Pachymetry: 479 µm. Gender: M.
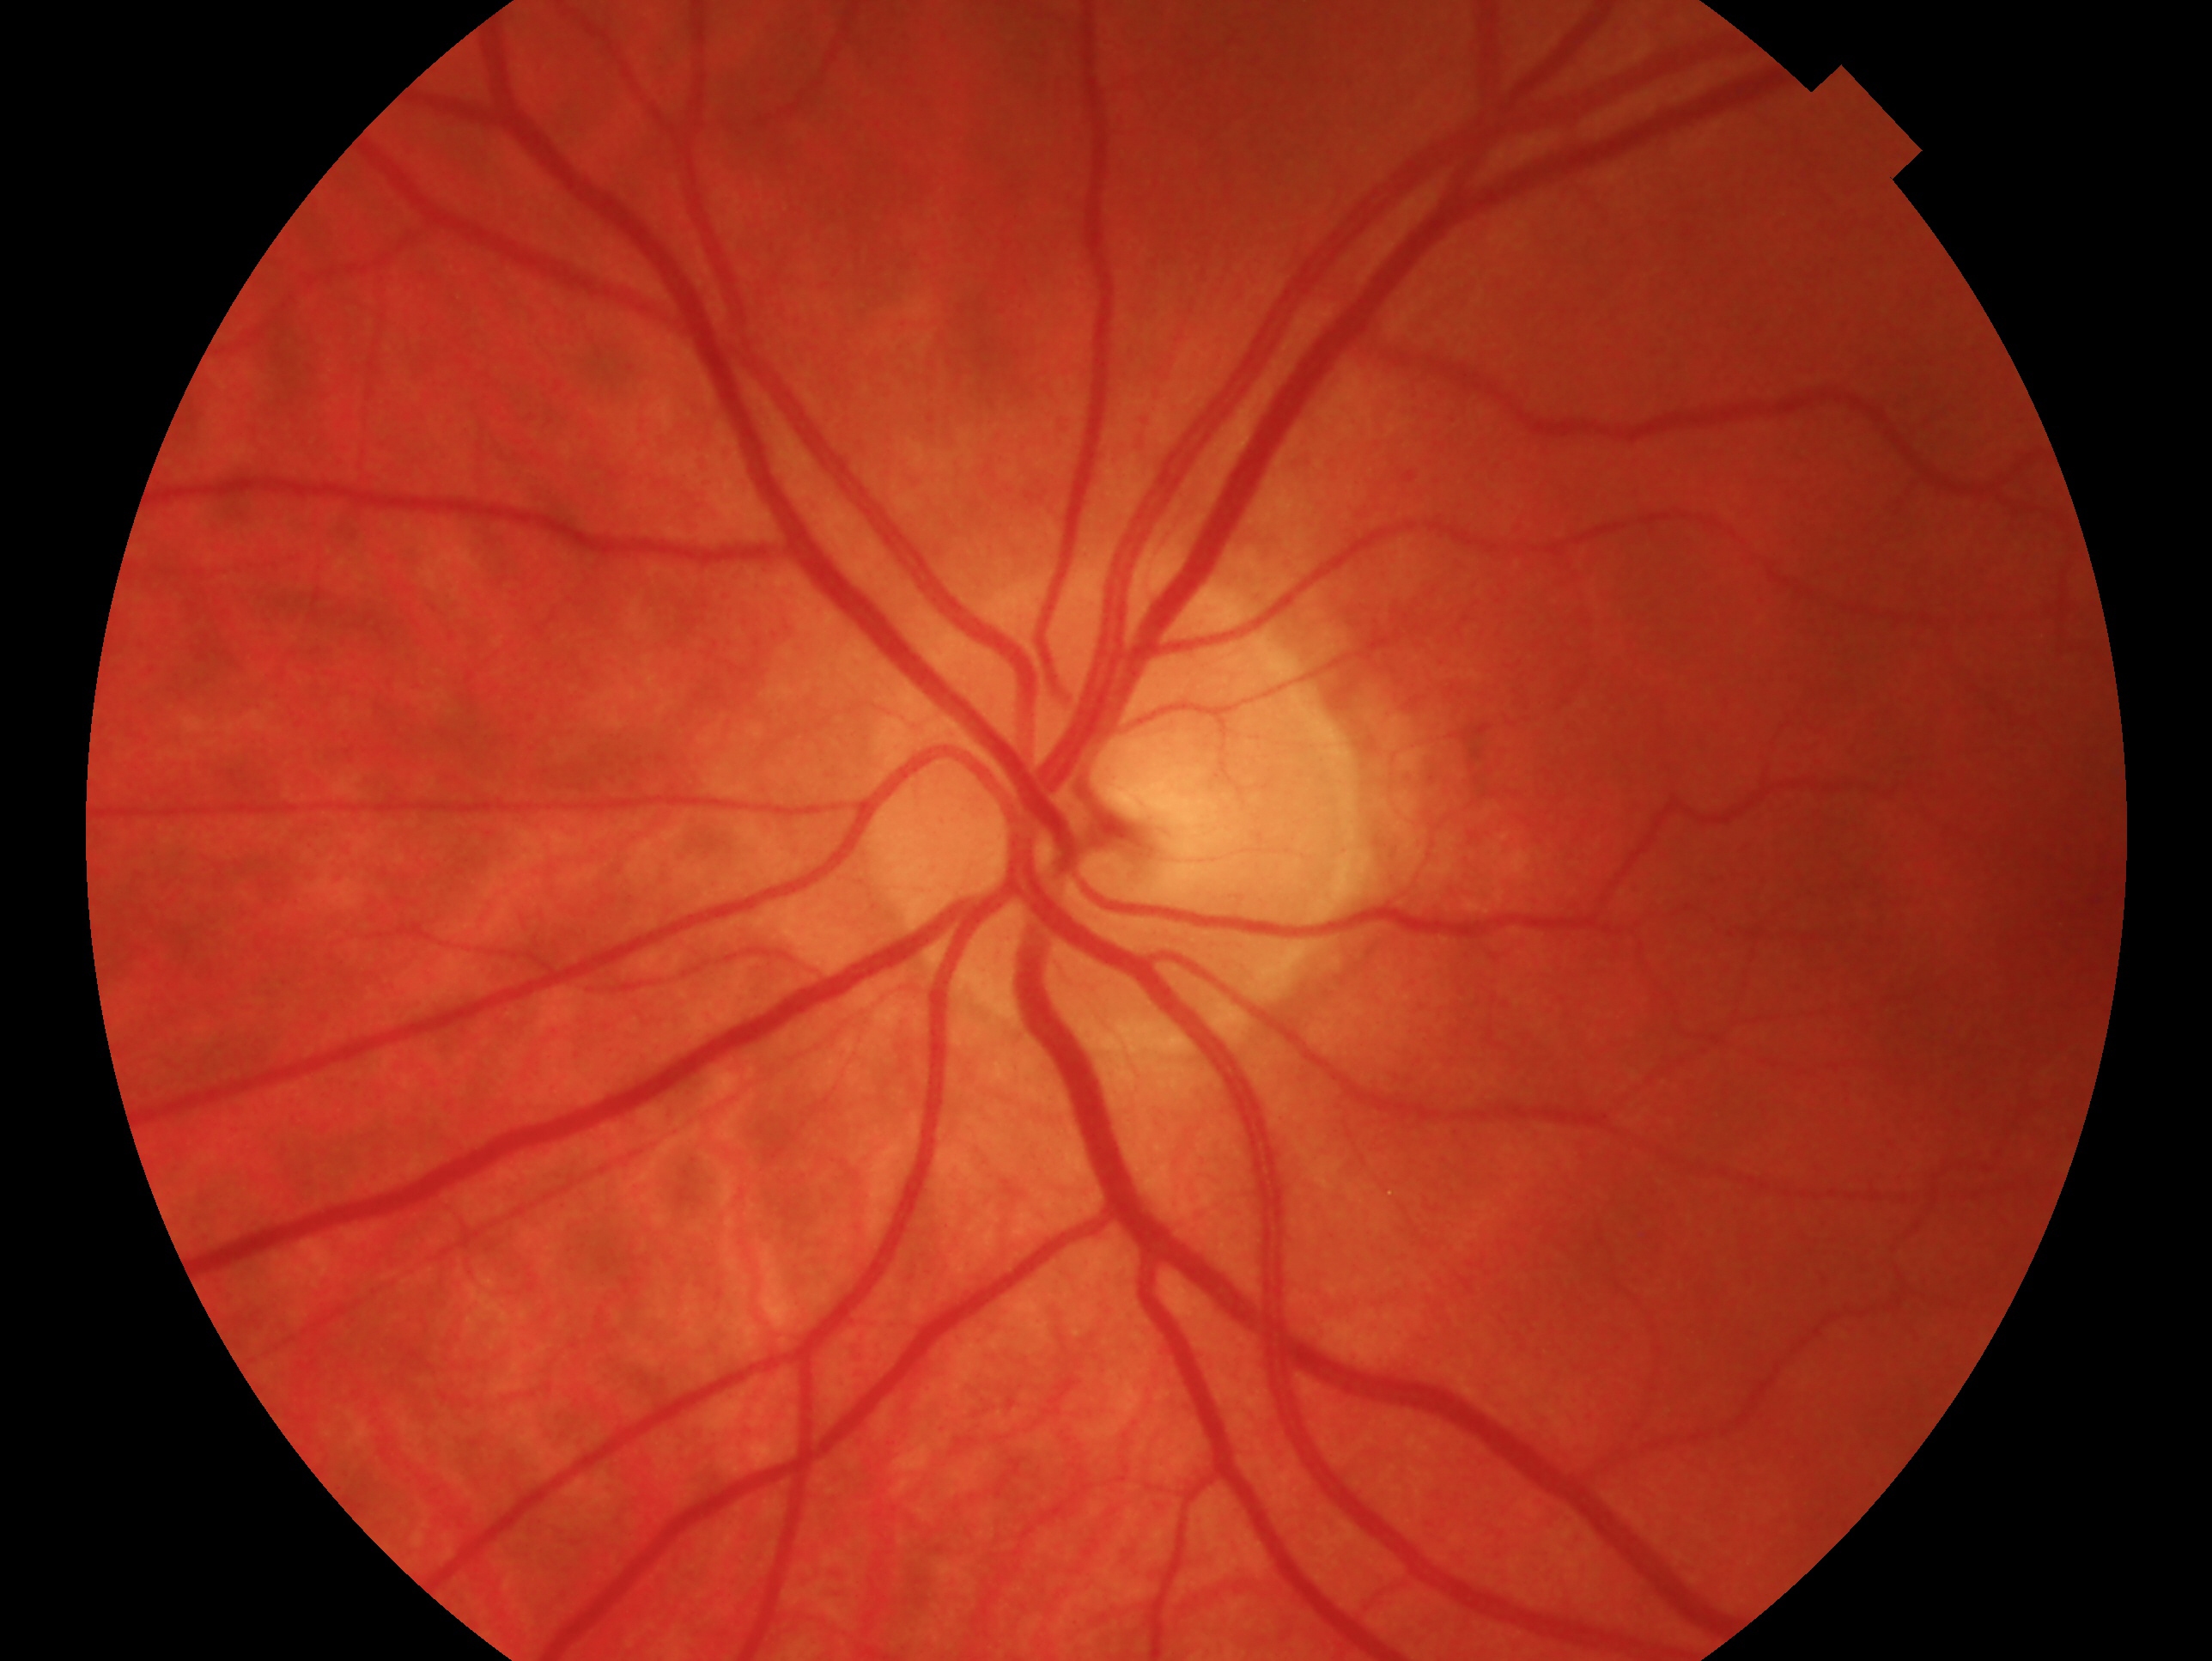

impression = no glaucomatous findings — no clinical evidence of glaucoma in this eye
laterality = left